50° field of view, retinal fundus photograph: 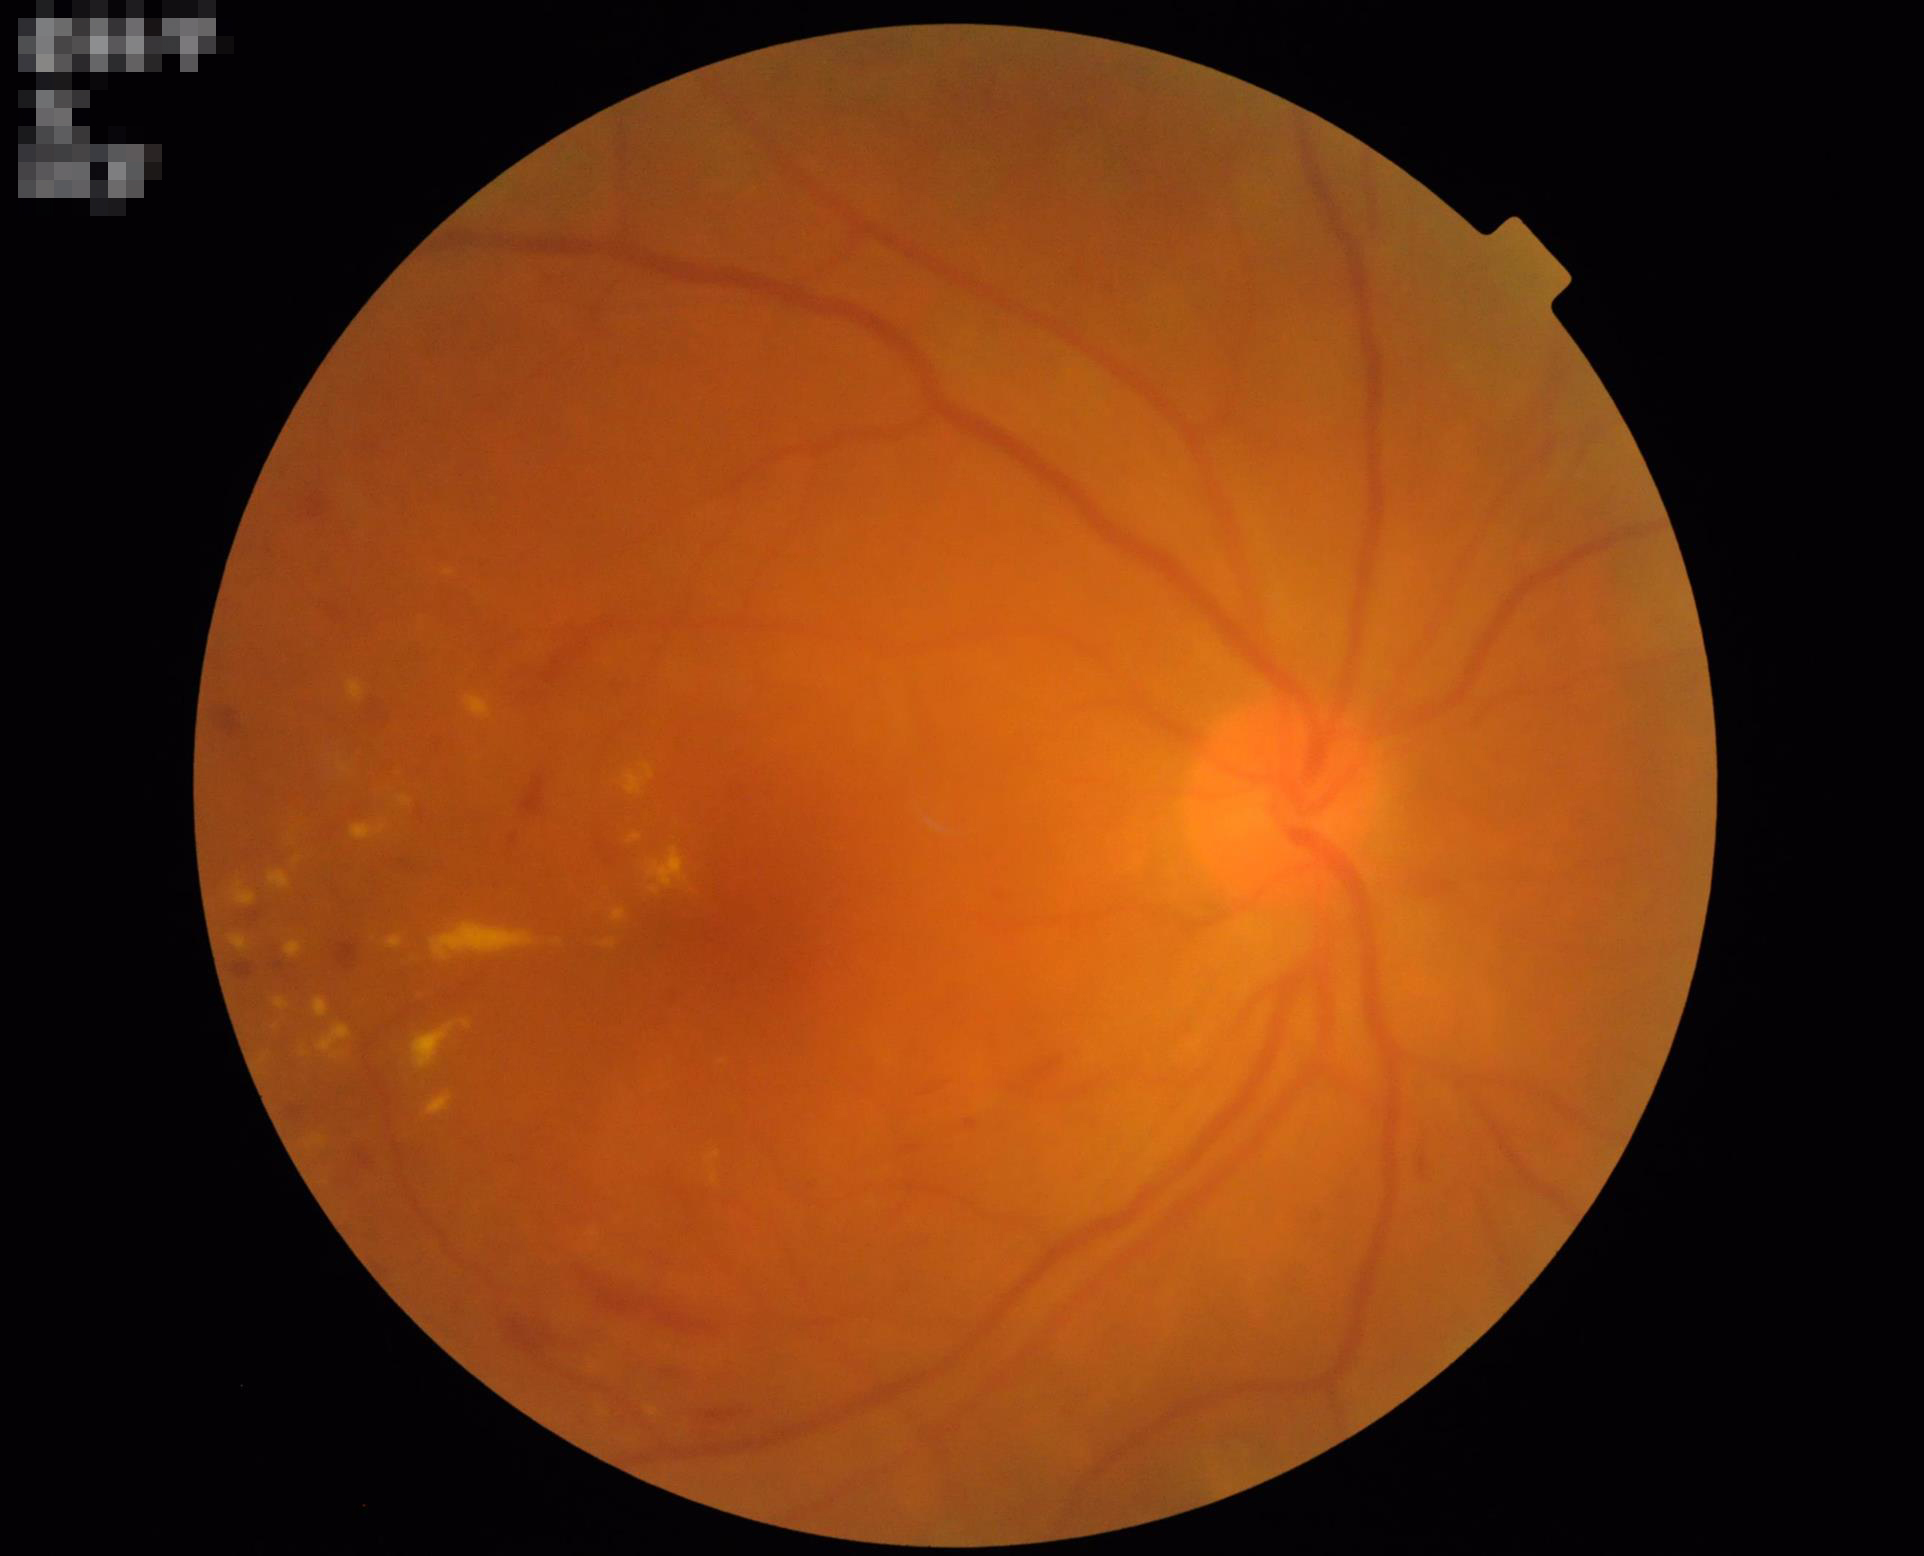 Noticeable blur in the optic disc, vessels, or background.
Good dynamic range.
Overall image quality is poor.
Even illumination with no color cast.